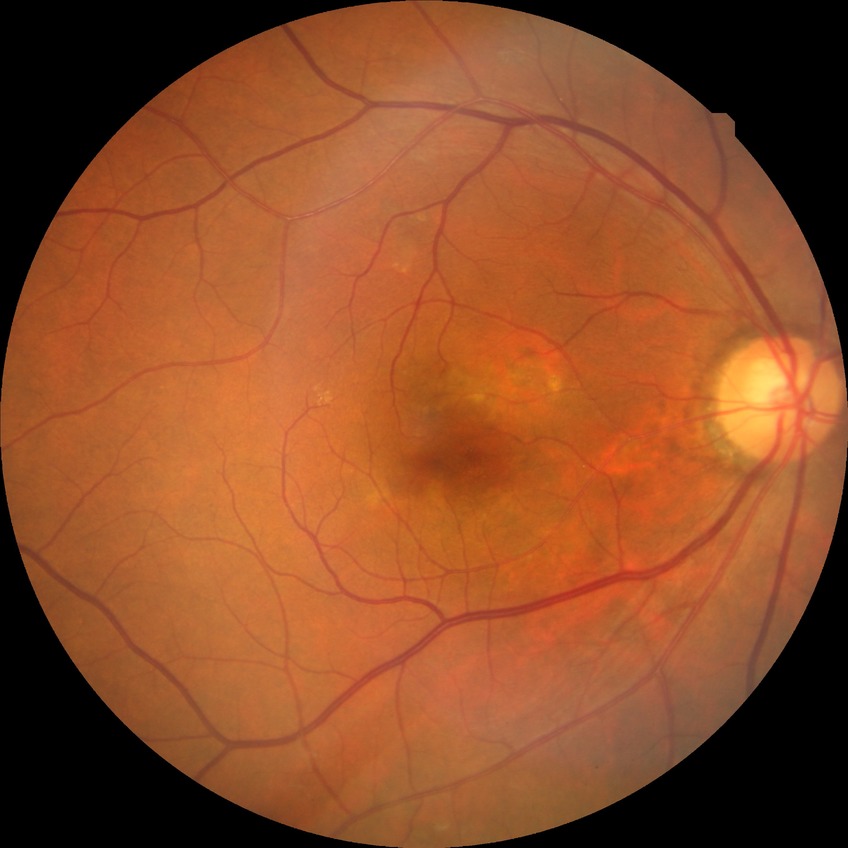 Assessment:
- diabetic retinopathy (DR): no diabetic retinopathy (NDR)